848 x 848 pixels; diabetic retinopathy graded by the modified Davis classification; nonmydriatic; 45-degree field of view
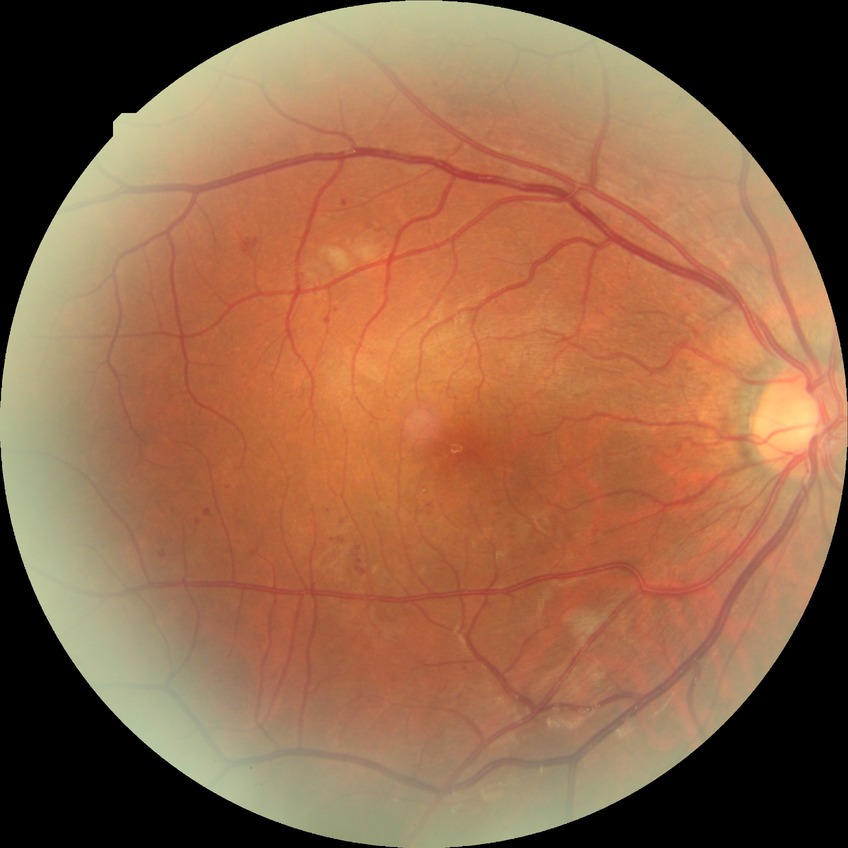

Diabetic retinopathy (DR): pre-proliferative diabetic retinopathy (PPDR).